Retinal fundus photograph.
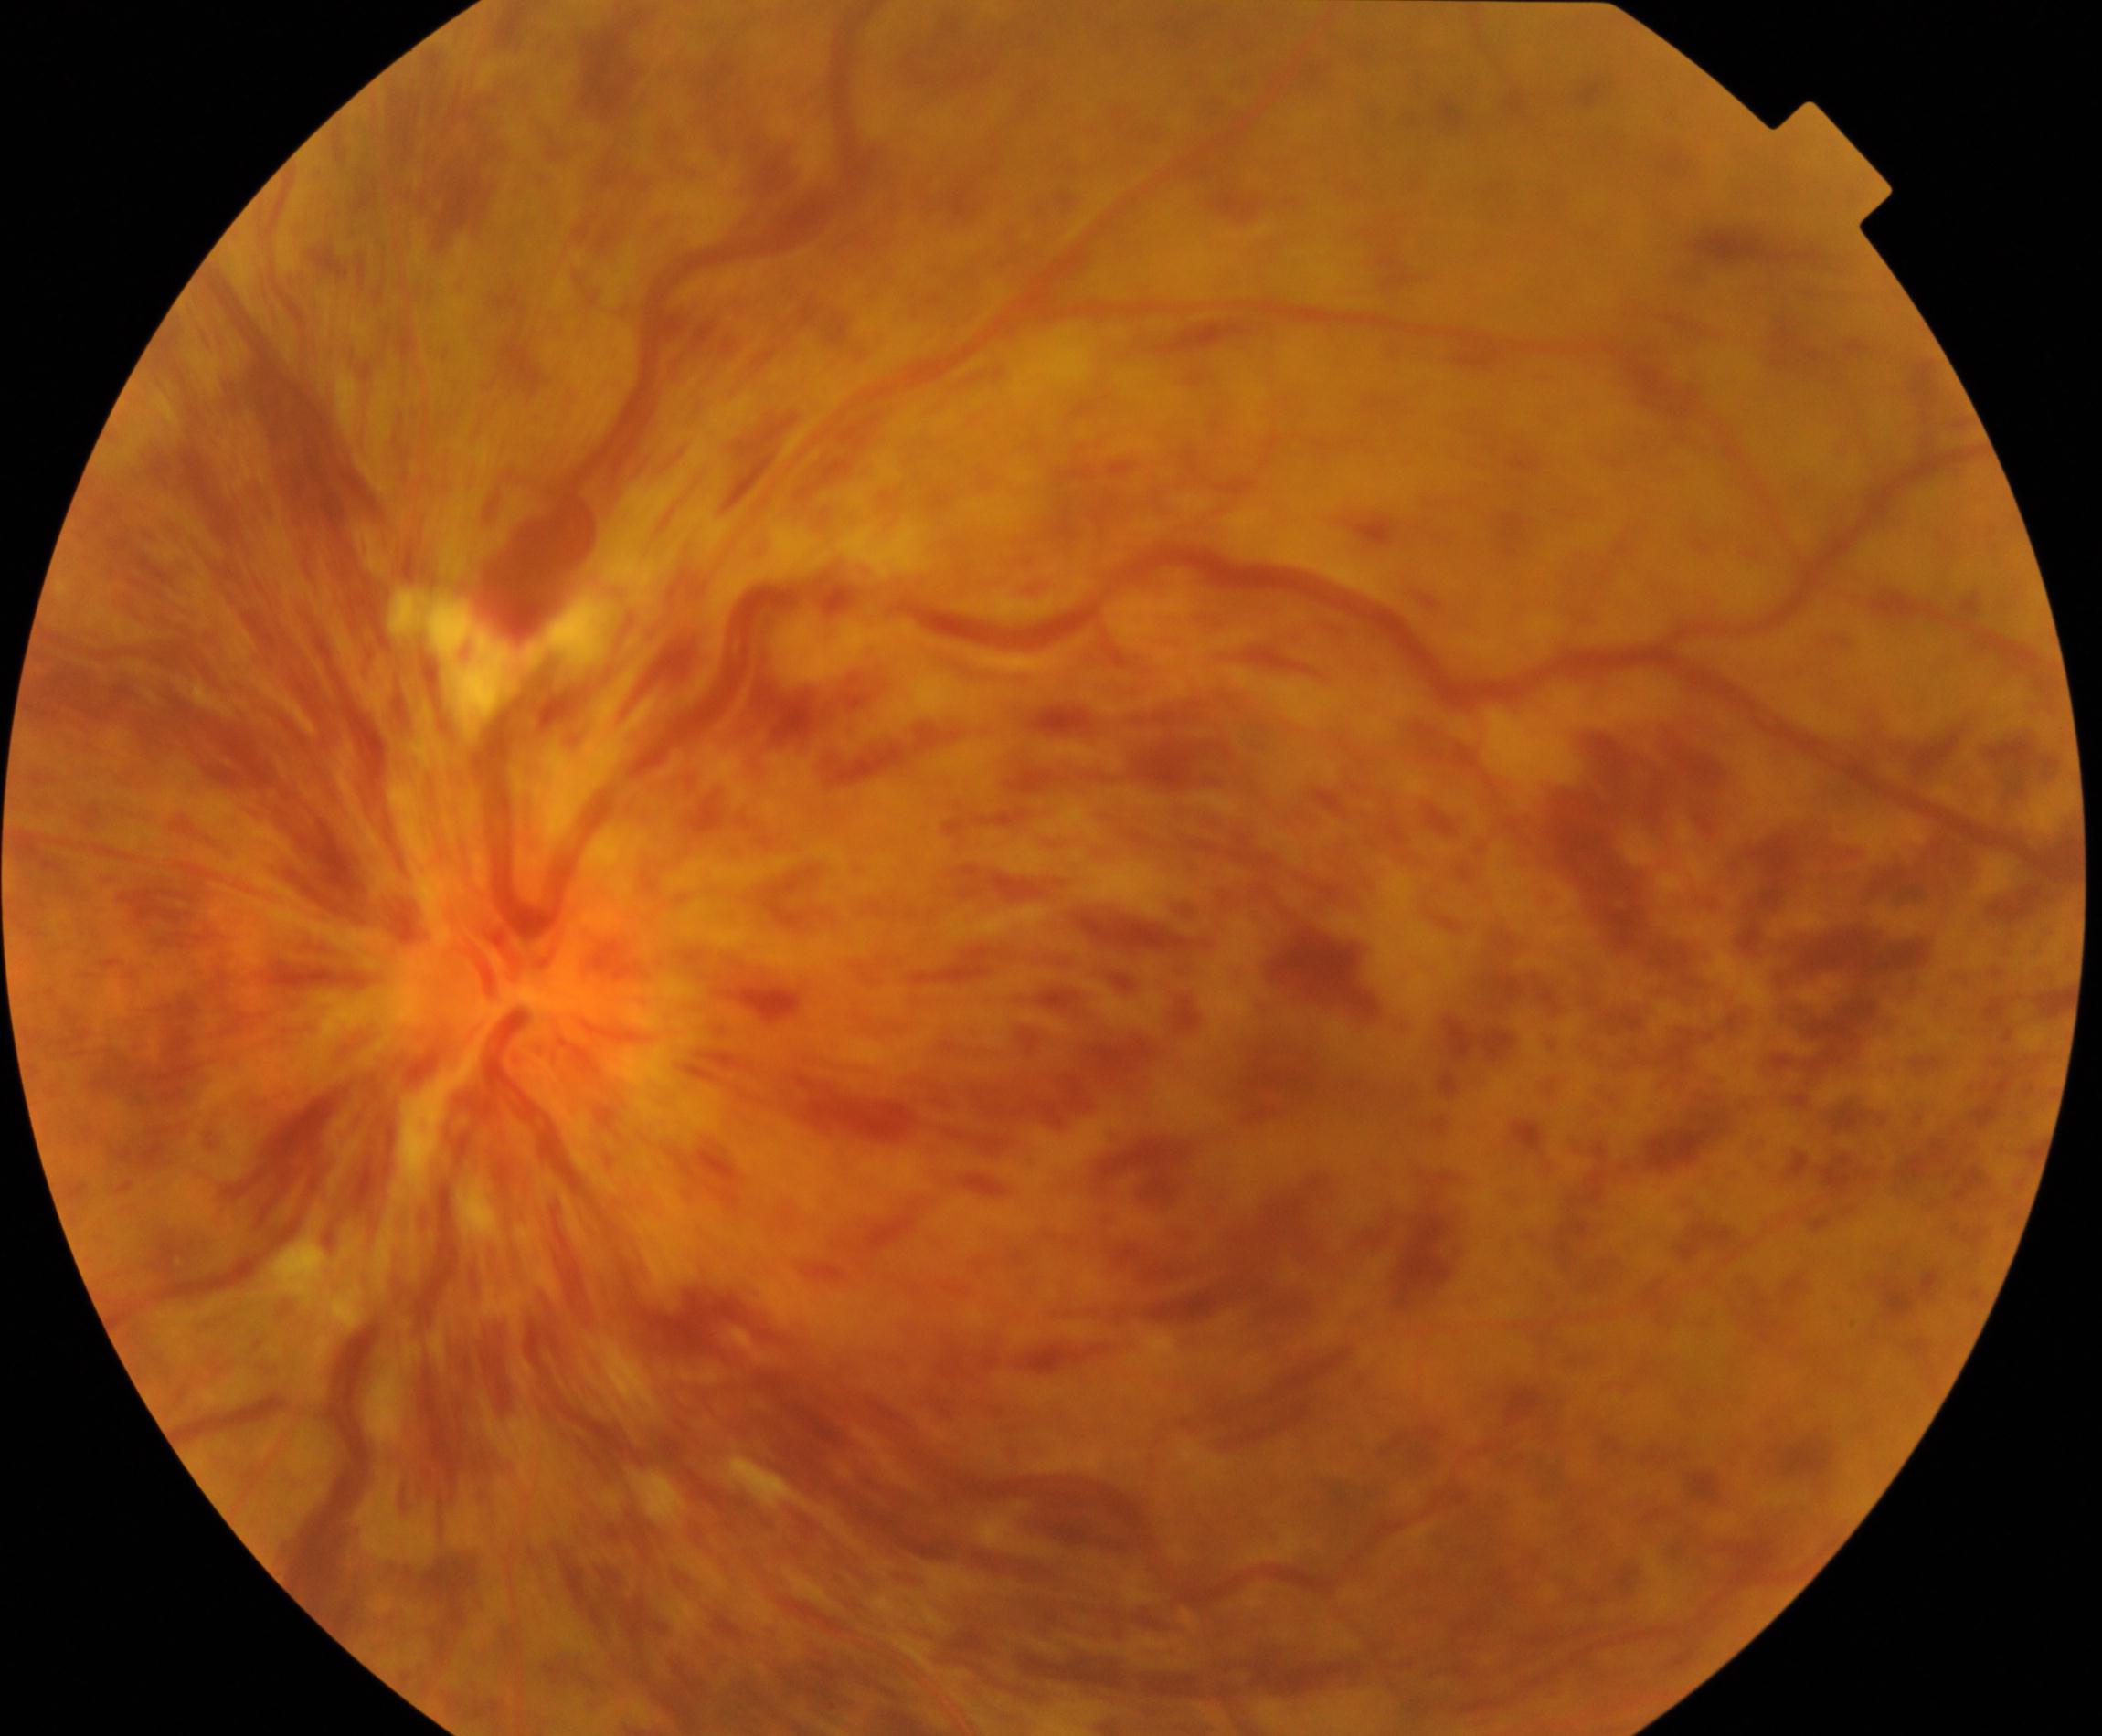 The image shows central retinal vein occlusion (CRVO).